Infant wide-field retinal image
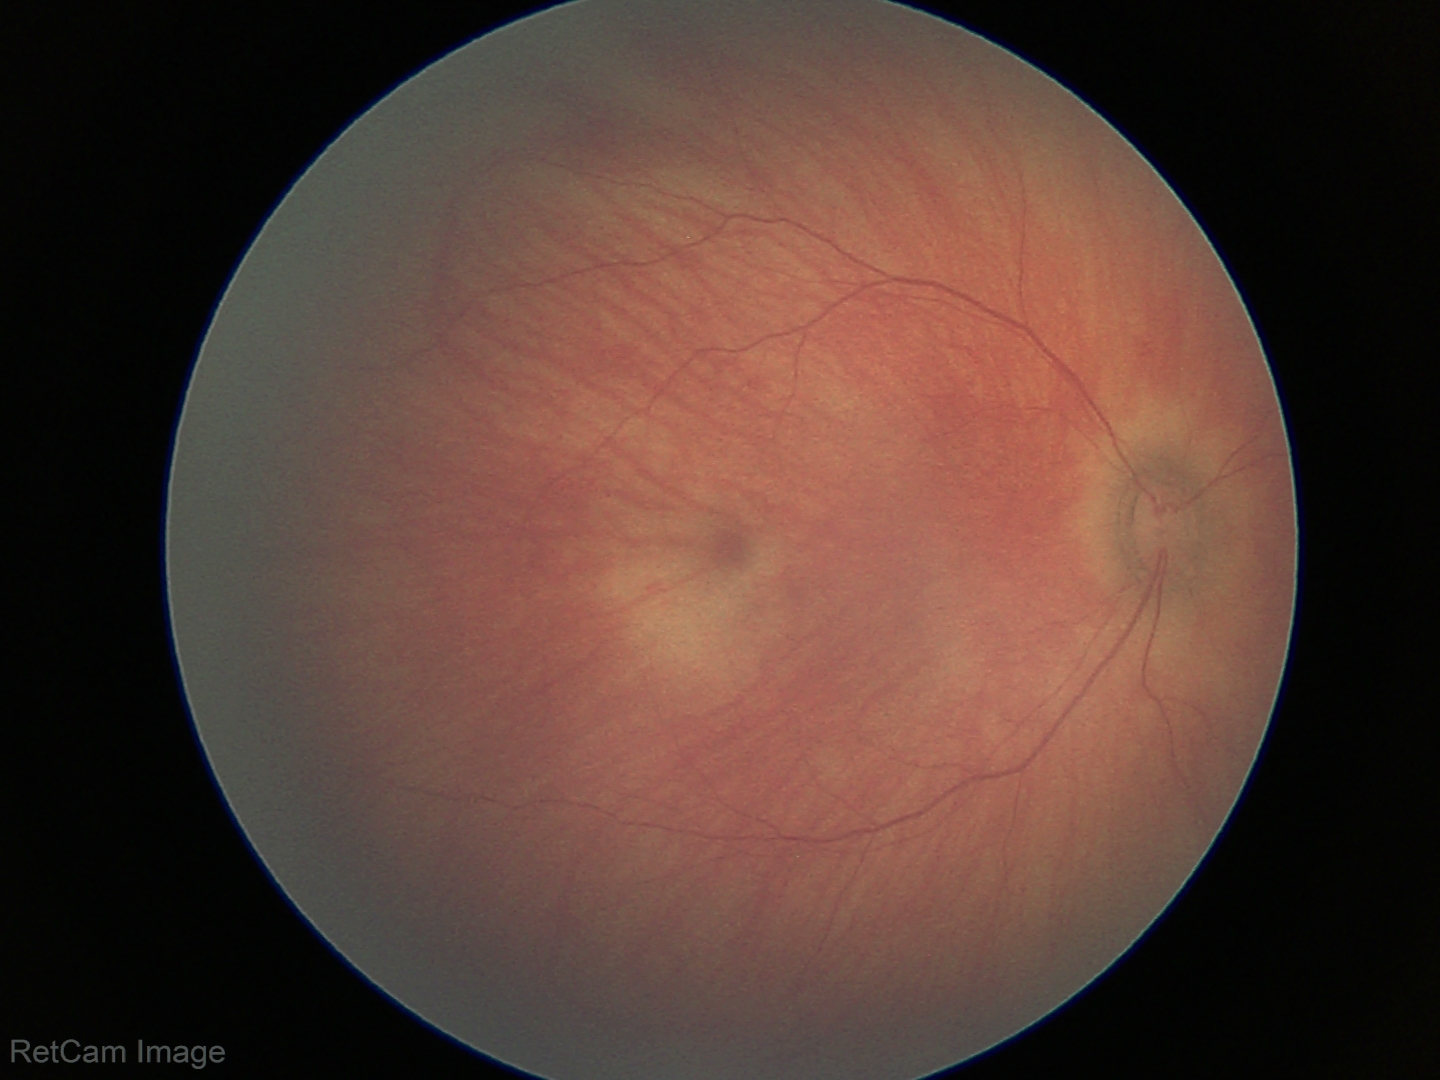 Examination with physiological retinal findings.